Image size 2361x1568; 50-degree field of view; camera: Kowa VX-10α; captured after pupil dilation.
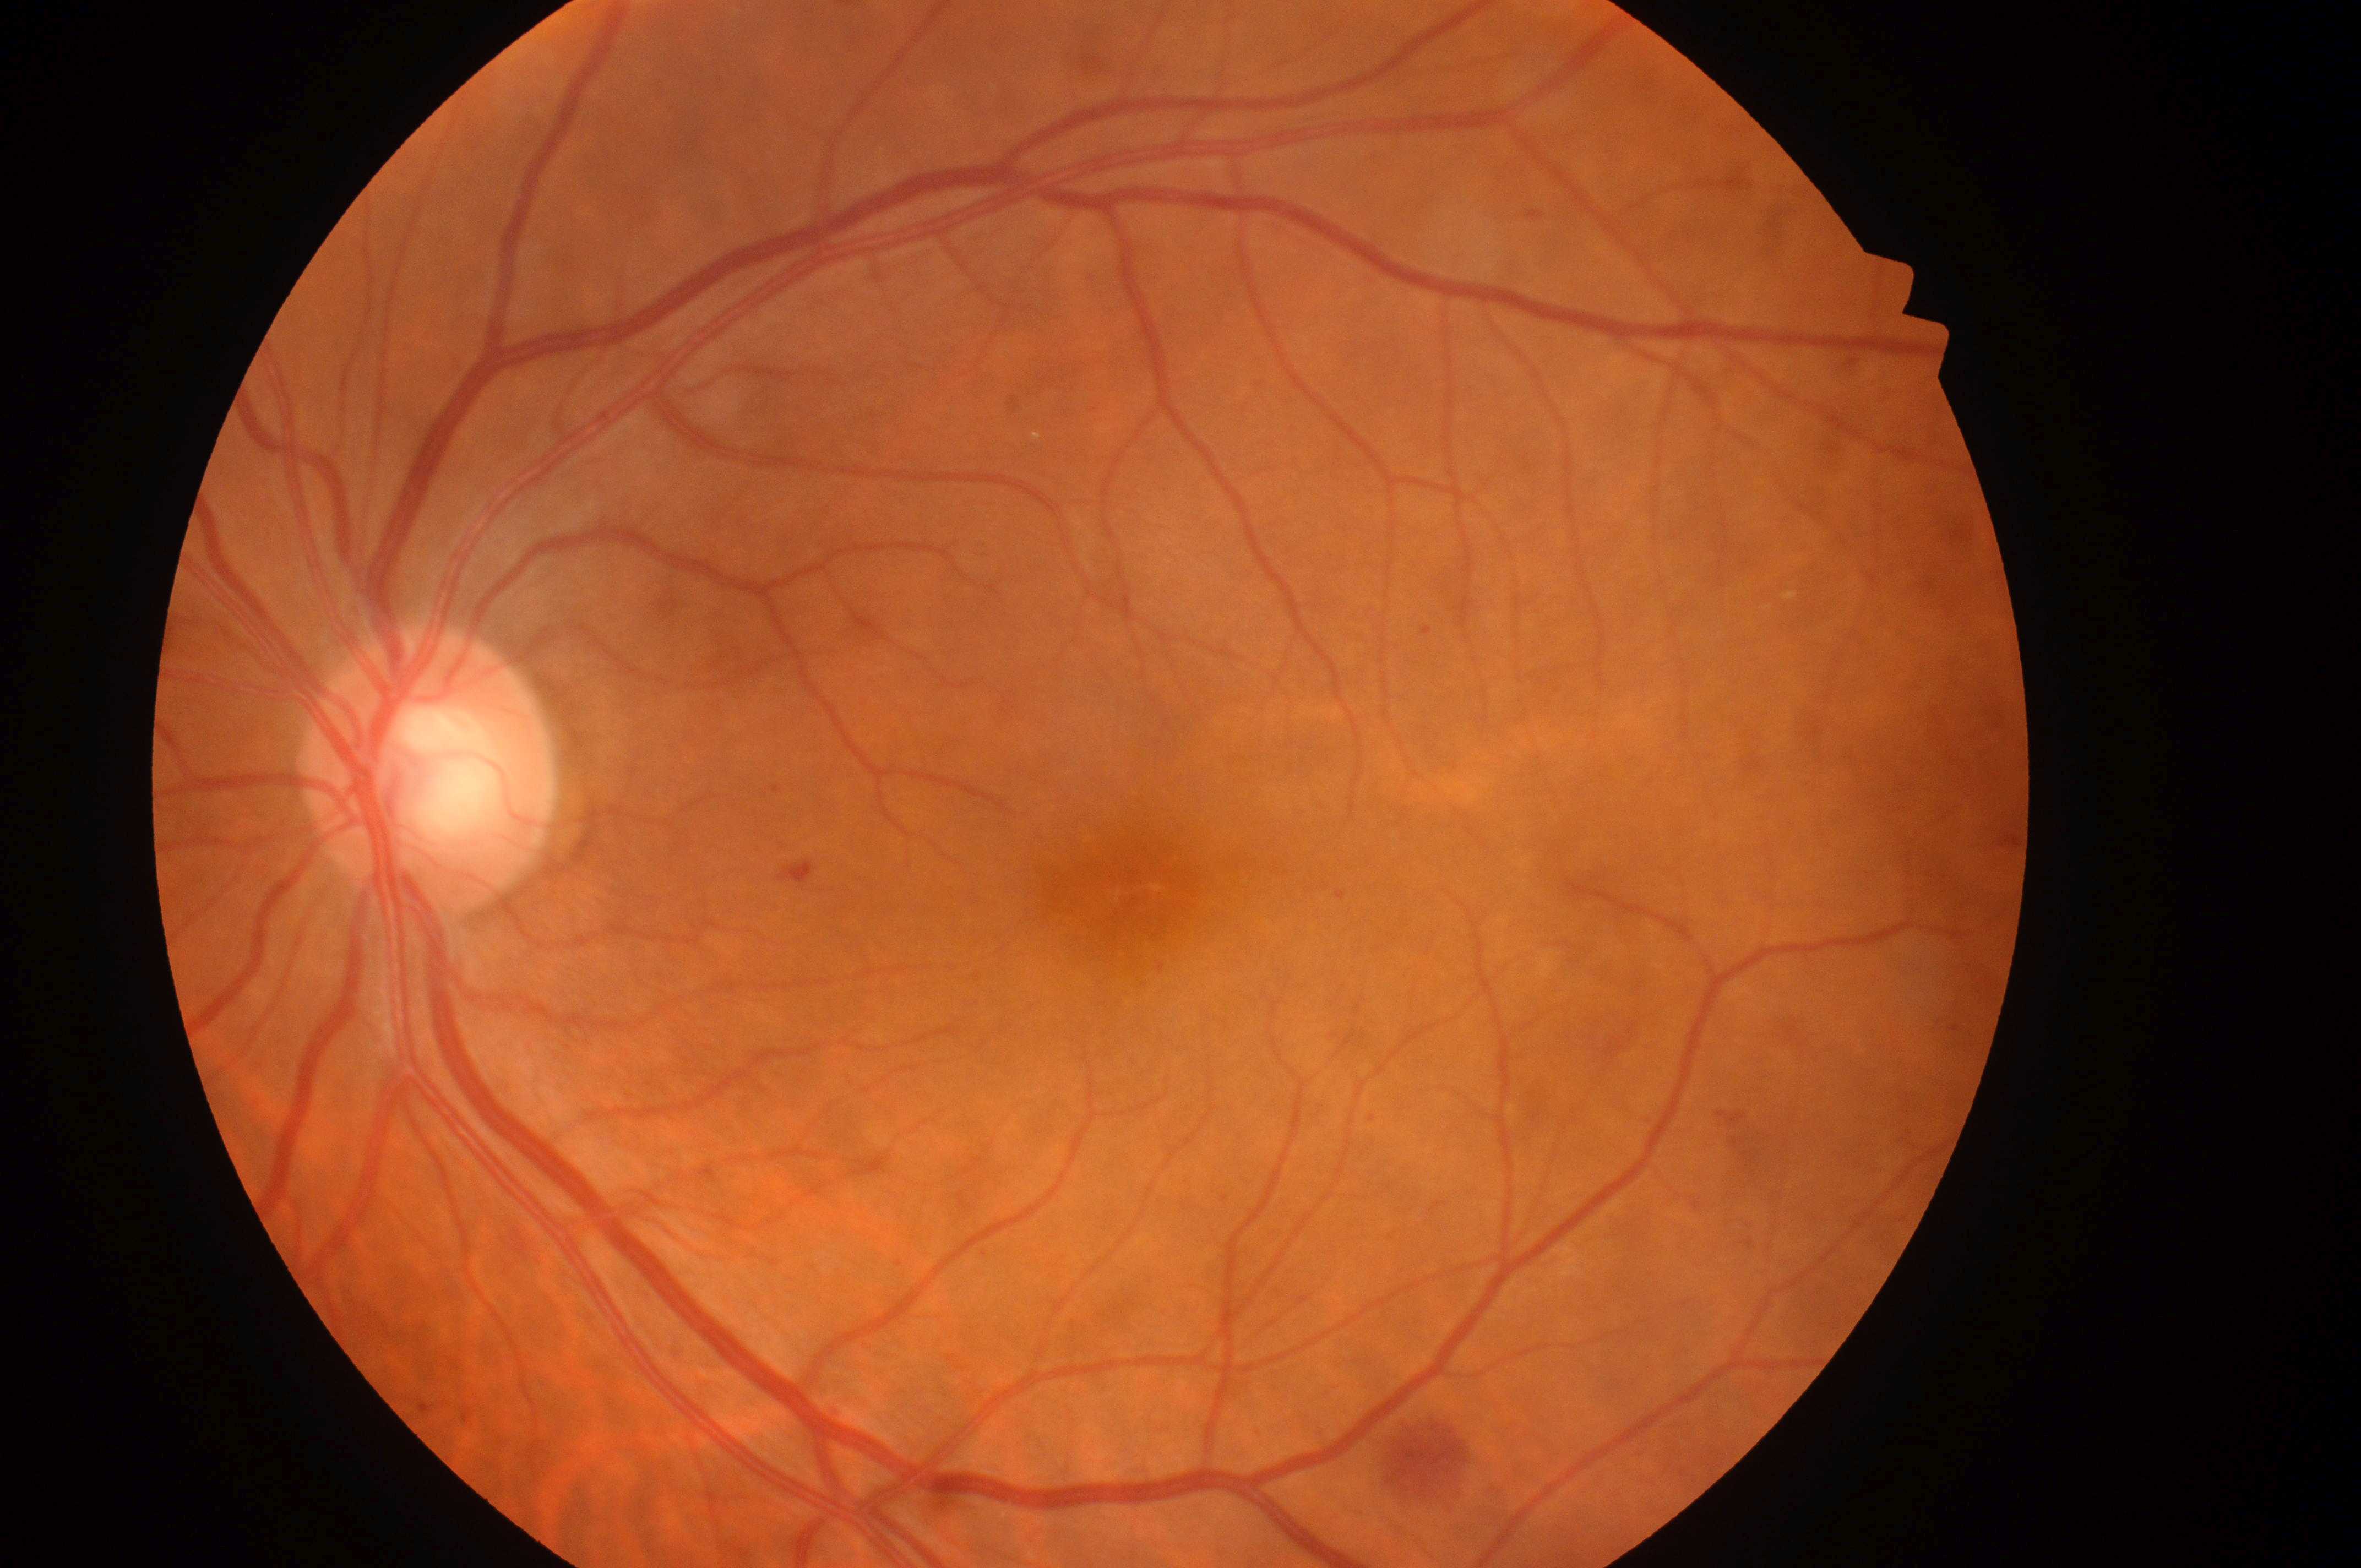

Q: Which eye is imaged?
A: the left eye
Q: DME grade?
A: no risk (grade 0)
Q: Optic disc center?
A: (x=425, y=781)
Q: What is the DR grade?
A: grade 2 (moderate NPDR)
Q: What disease class is present?
A: non-proliferative diabetic retinopathy
Q: Where is the fovea?
A: (x=1128, y=895)